240x240px
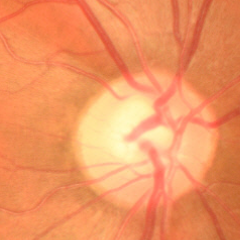

This fundus photograph shows early-stage glaucoma.